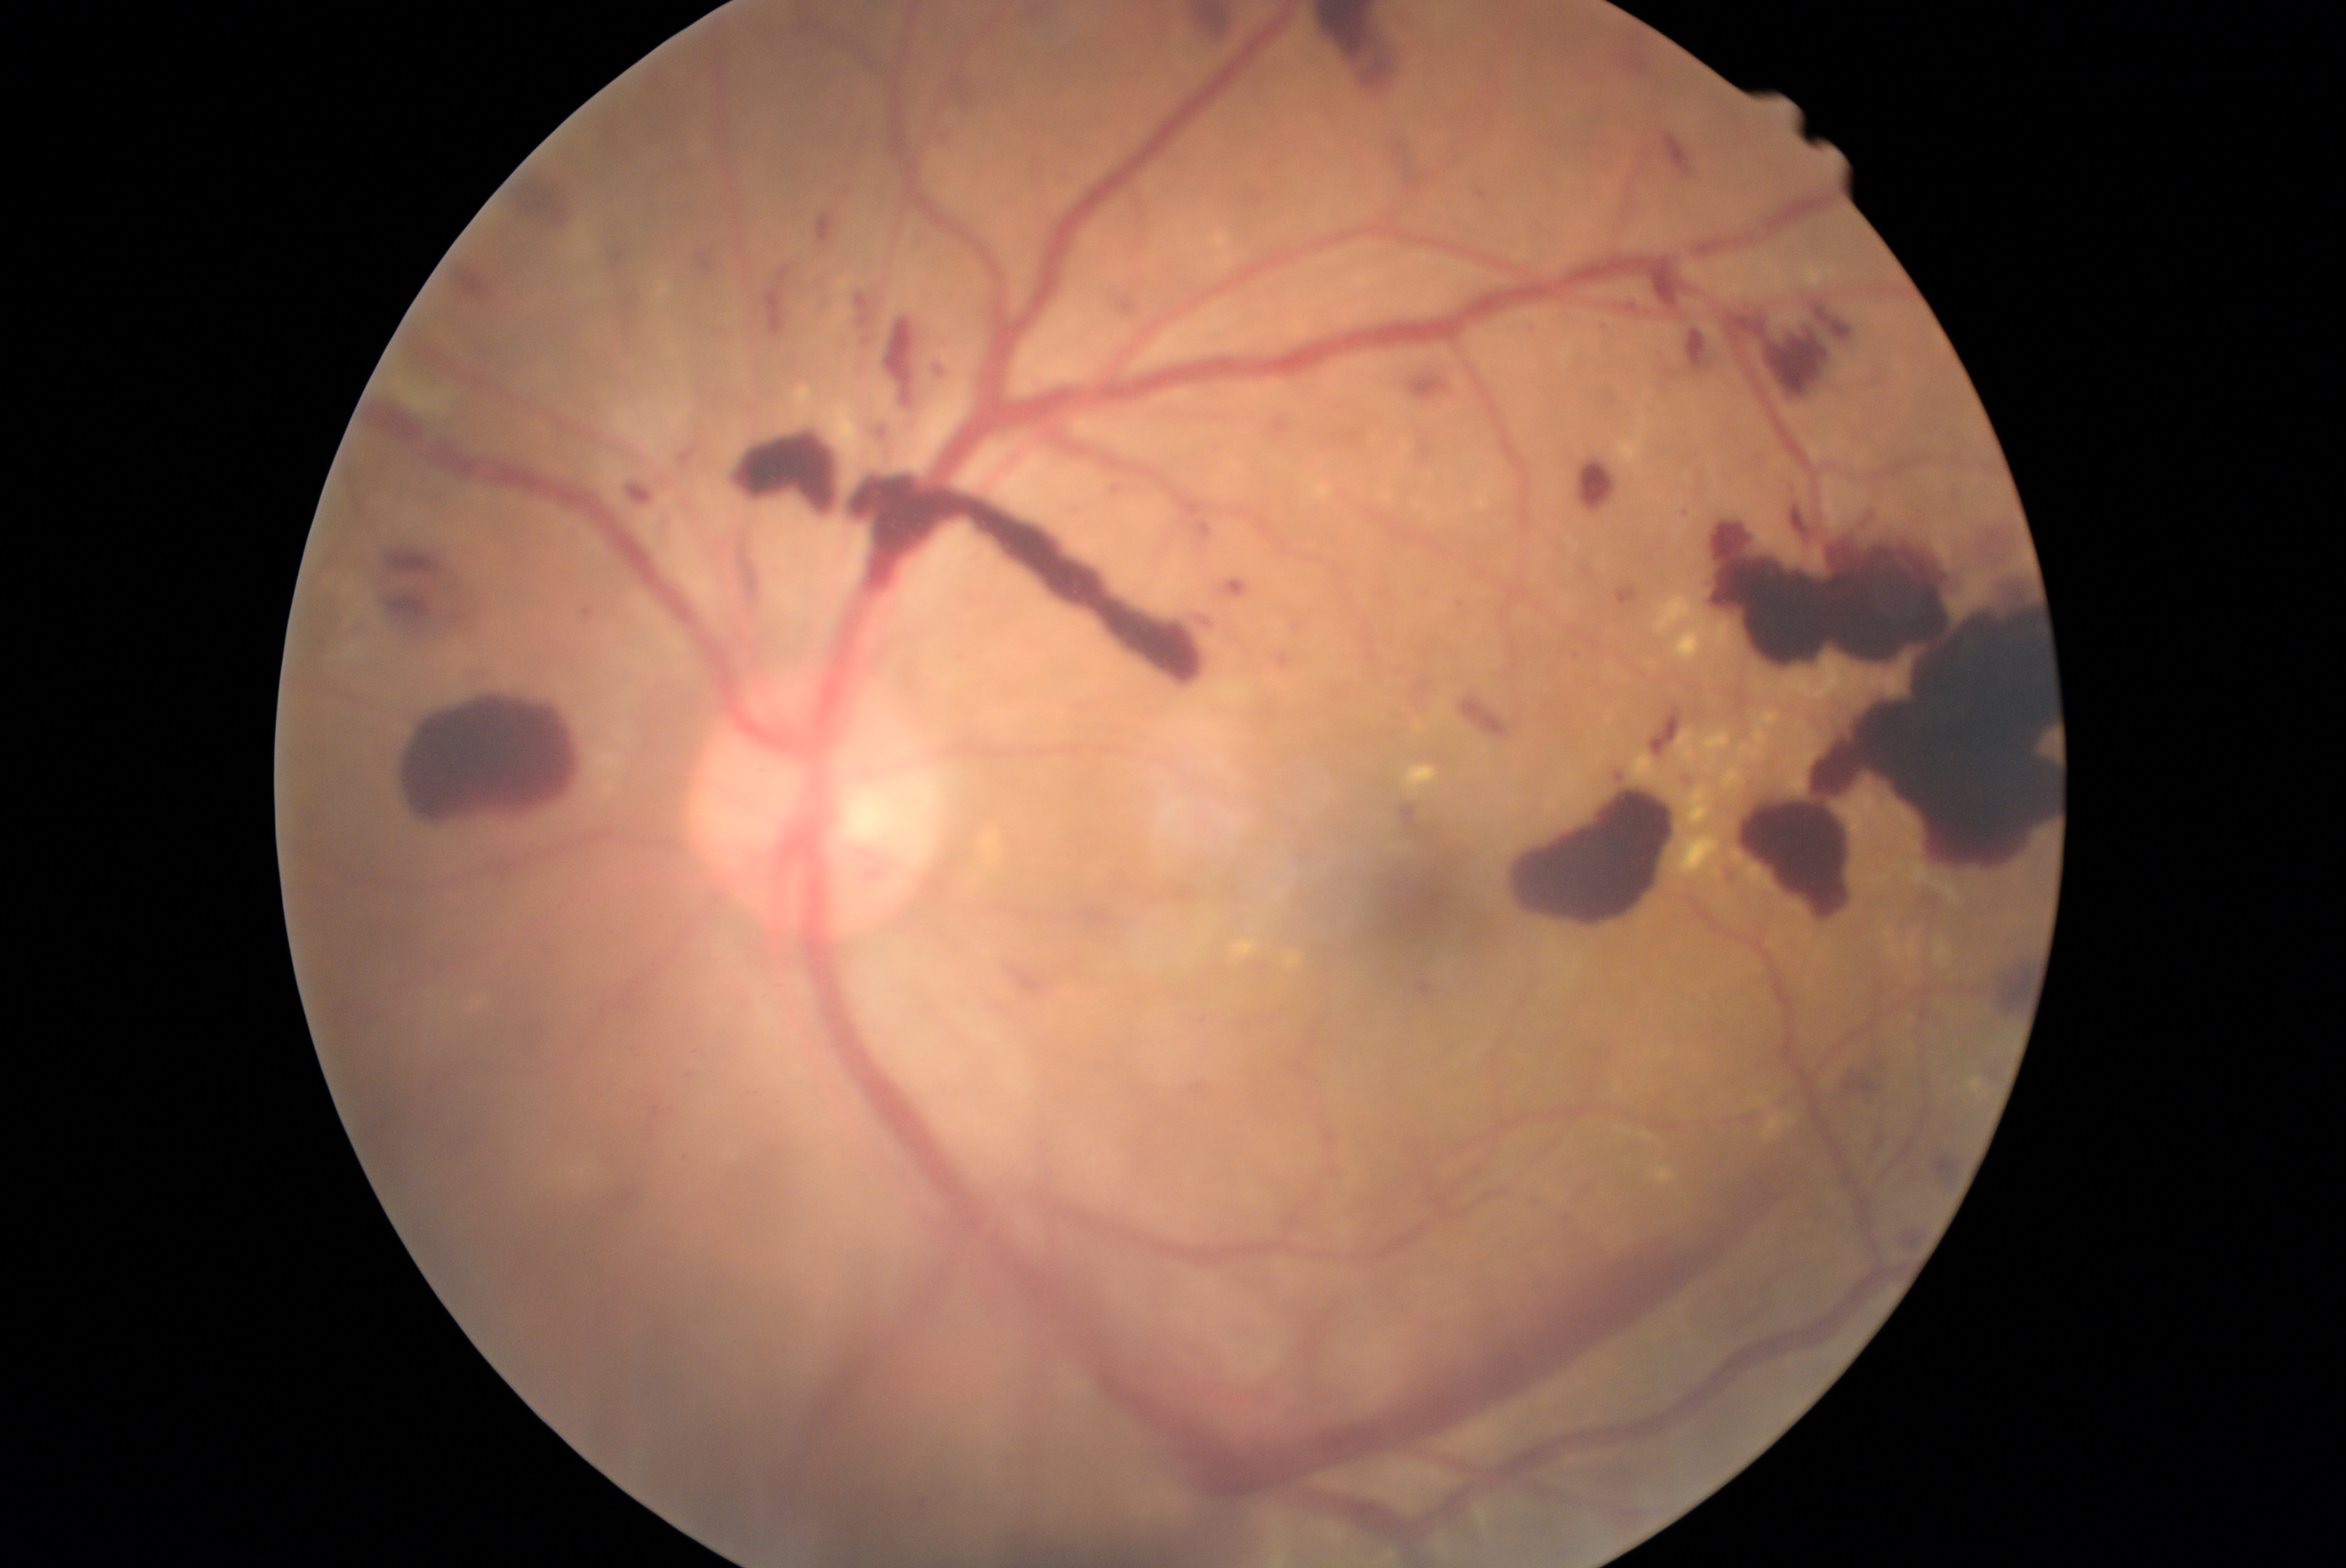

Retinopathy is PDR (grade 4)
Selected lesions:
- hemorrhages (more not shown): [1014, 1, 1070, 38]; [1696, 484, 2054, 921]; [1417, 973, 1445, 1000]; [766, 255, 829, 335]; [816, 212, 838, 250]; [1273, 412, 1295, 434]; [1373, 799, 1513, 964]; [1594, 321, 1614, 338]; [678, 446, 703, 470]; [779, 355, 801, 376]; [1561, 1180, 1599, 1213]; [1658, 327, 1716, 387]; [612, 286, 642, 325]; [932, 134, 957, 145]; [1456, 598, 1469, 615]; [600, 239, 633, 272]; [1607, 31, 1657, 82]; [1661, 128, 1694, 178]
- hard exudates (more not shown): [1936, 942, 1950, 964]; [1752, 725, 1768, 760]; [1701, 730, 1732, 764]; [1669, 832, 1723, 891]; [1967, 1078, 1983, 1092]; [1285, 951, 1304, 968]; [1721, 768, 1743, 789]; [1677, 730, 1696, 768]; [1740, 744, 1748, 753]; [1762, 1114, 1796, 1142]
- Small hard exudates approximately at 1625:1129